Optic disc-centered. Autorefraction: -0.5 -0.75 x 92. Pachymetry 485 µm. Intraocular pressure by applanation tonometry: 12 mmHg. Woman patient. Axial length: 23.6 mm. Captured without pupil dilation. Camera: Topcon TRC-NW400. Color fundus image:
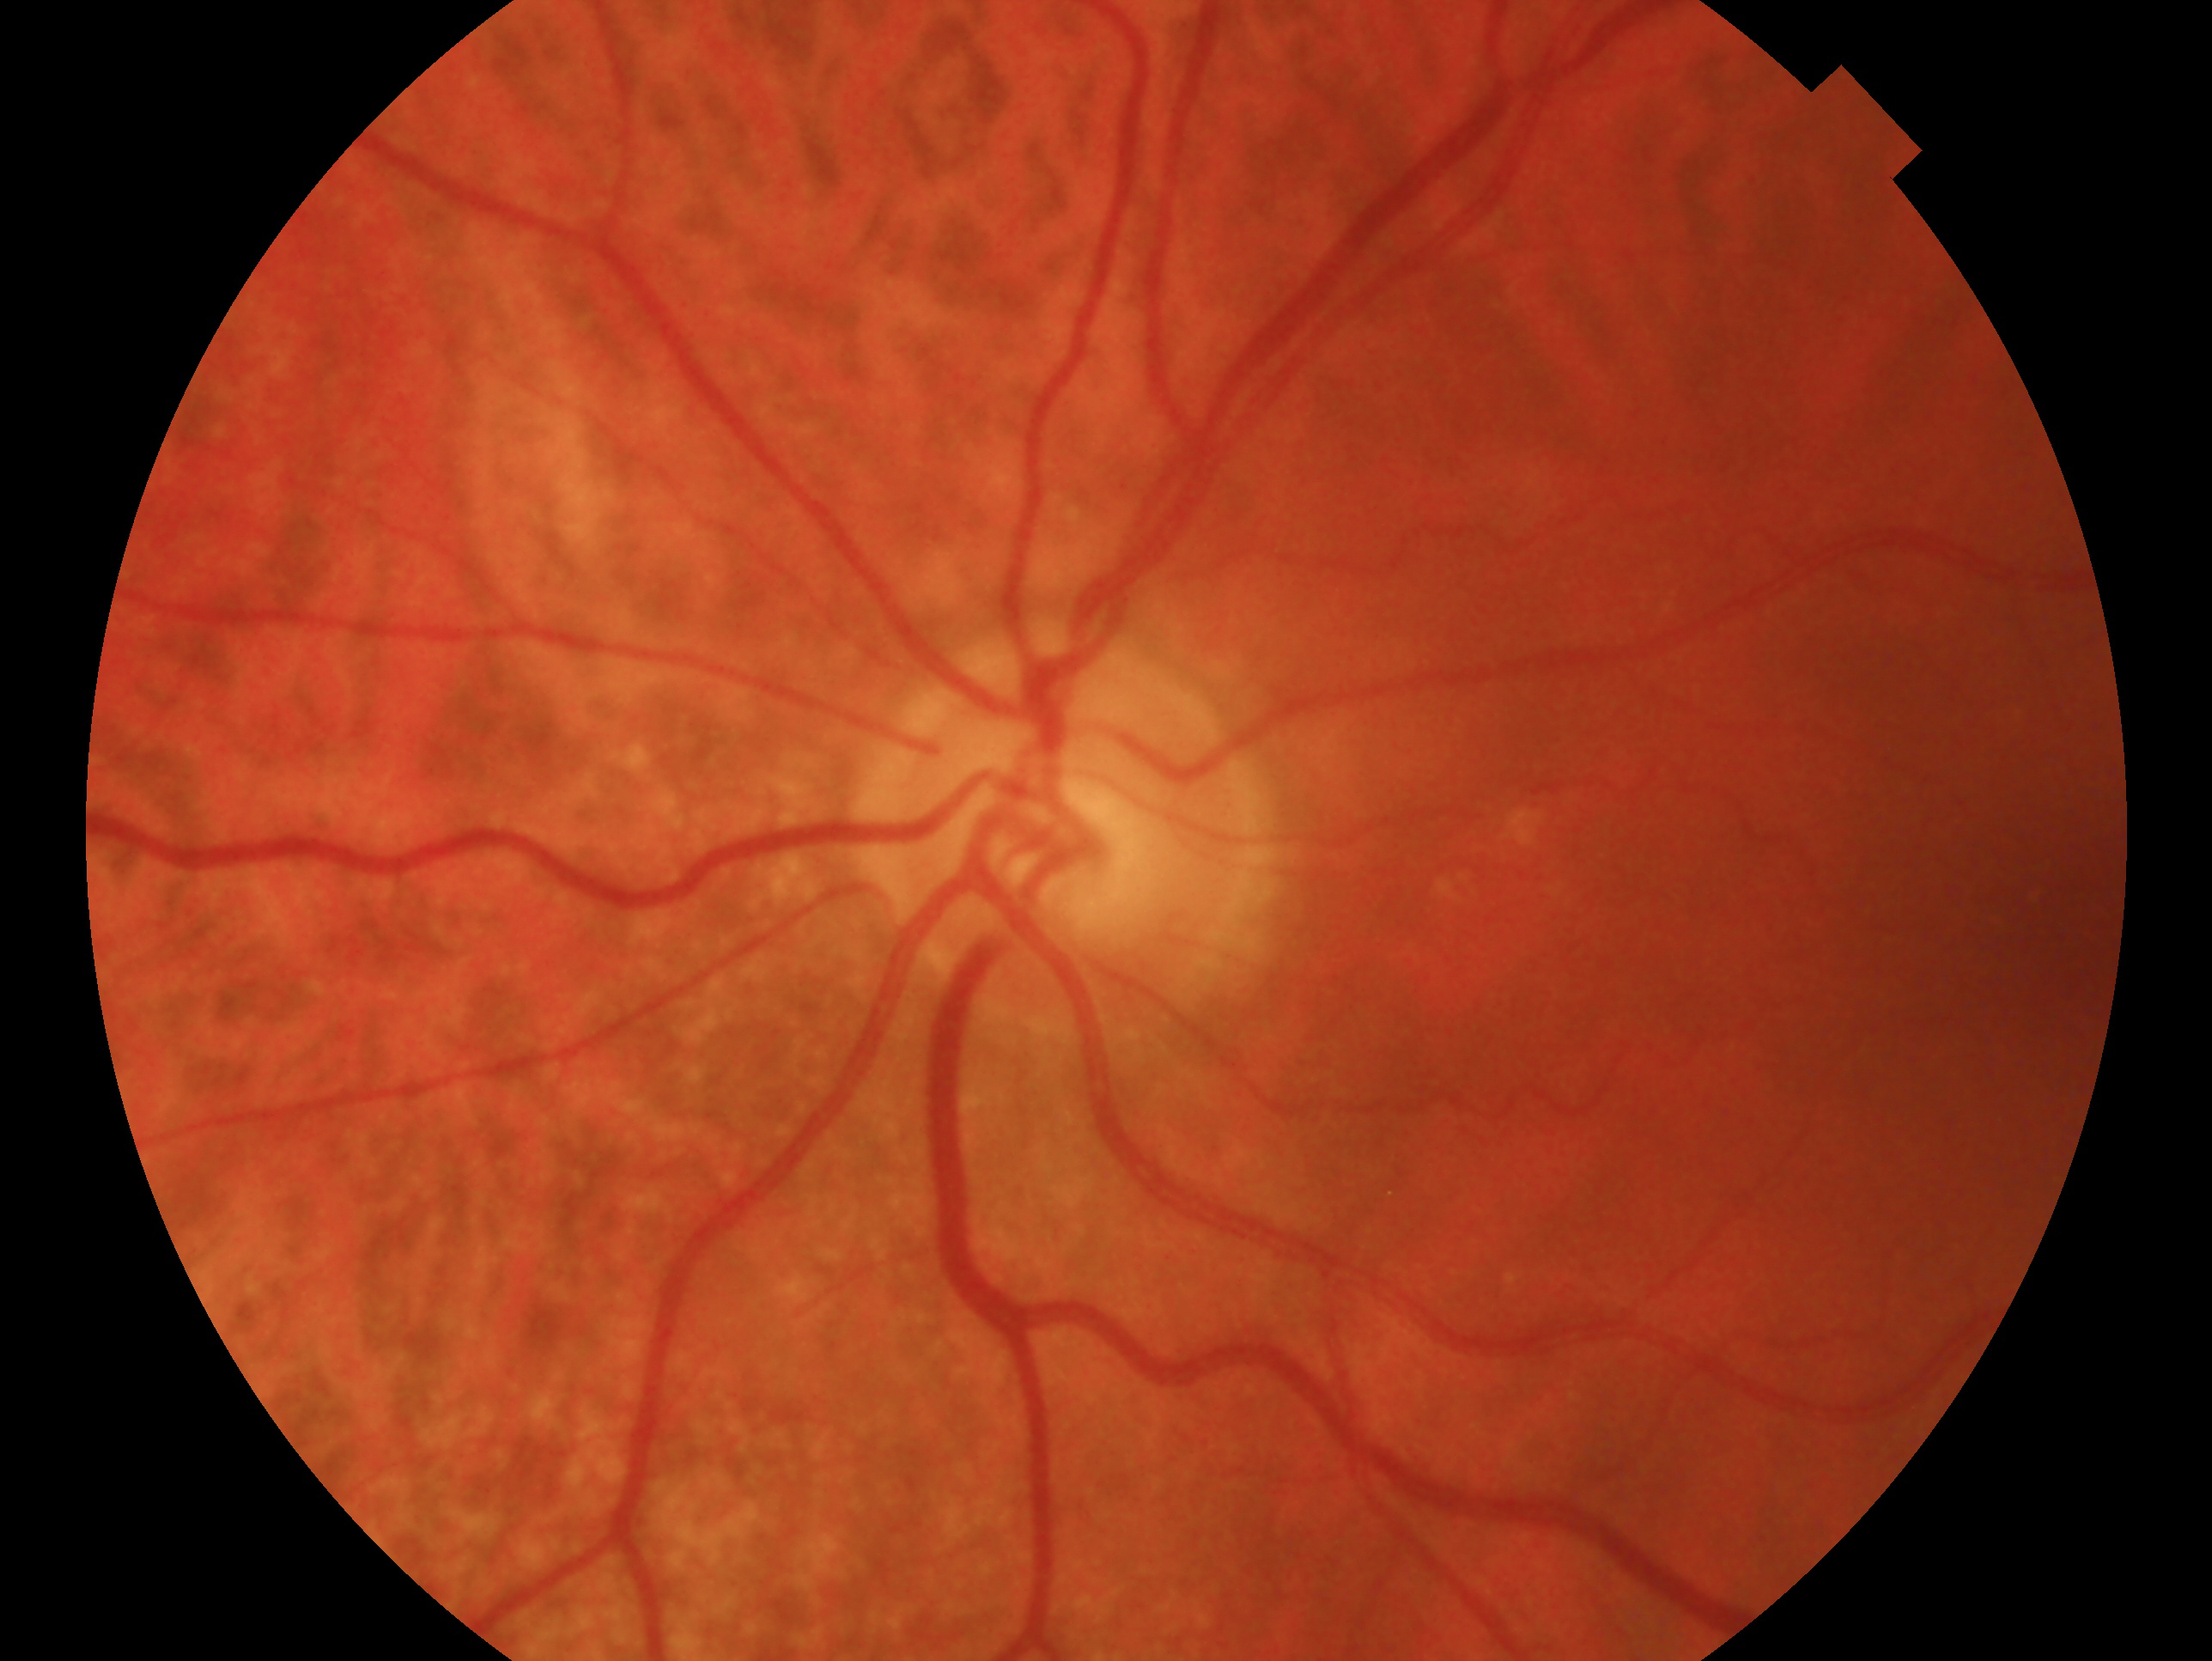

Imaged eye: left. Impression — glaucoma.